Posterior pole view · CFP: 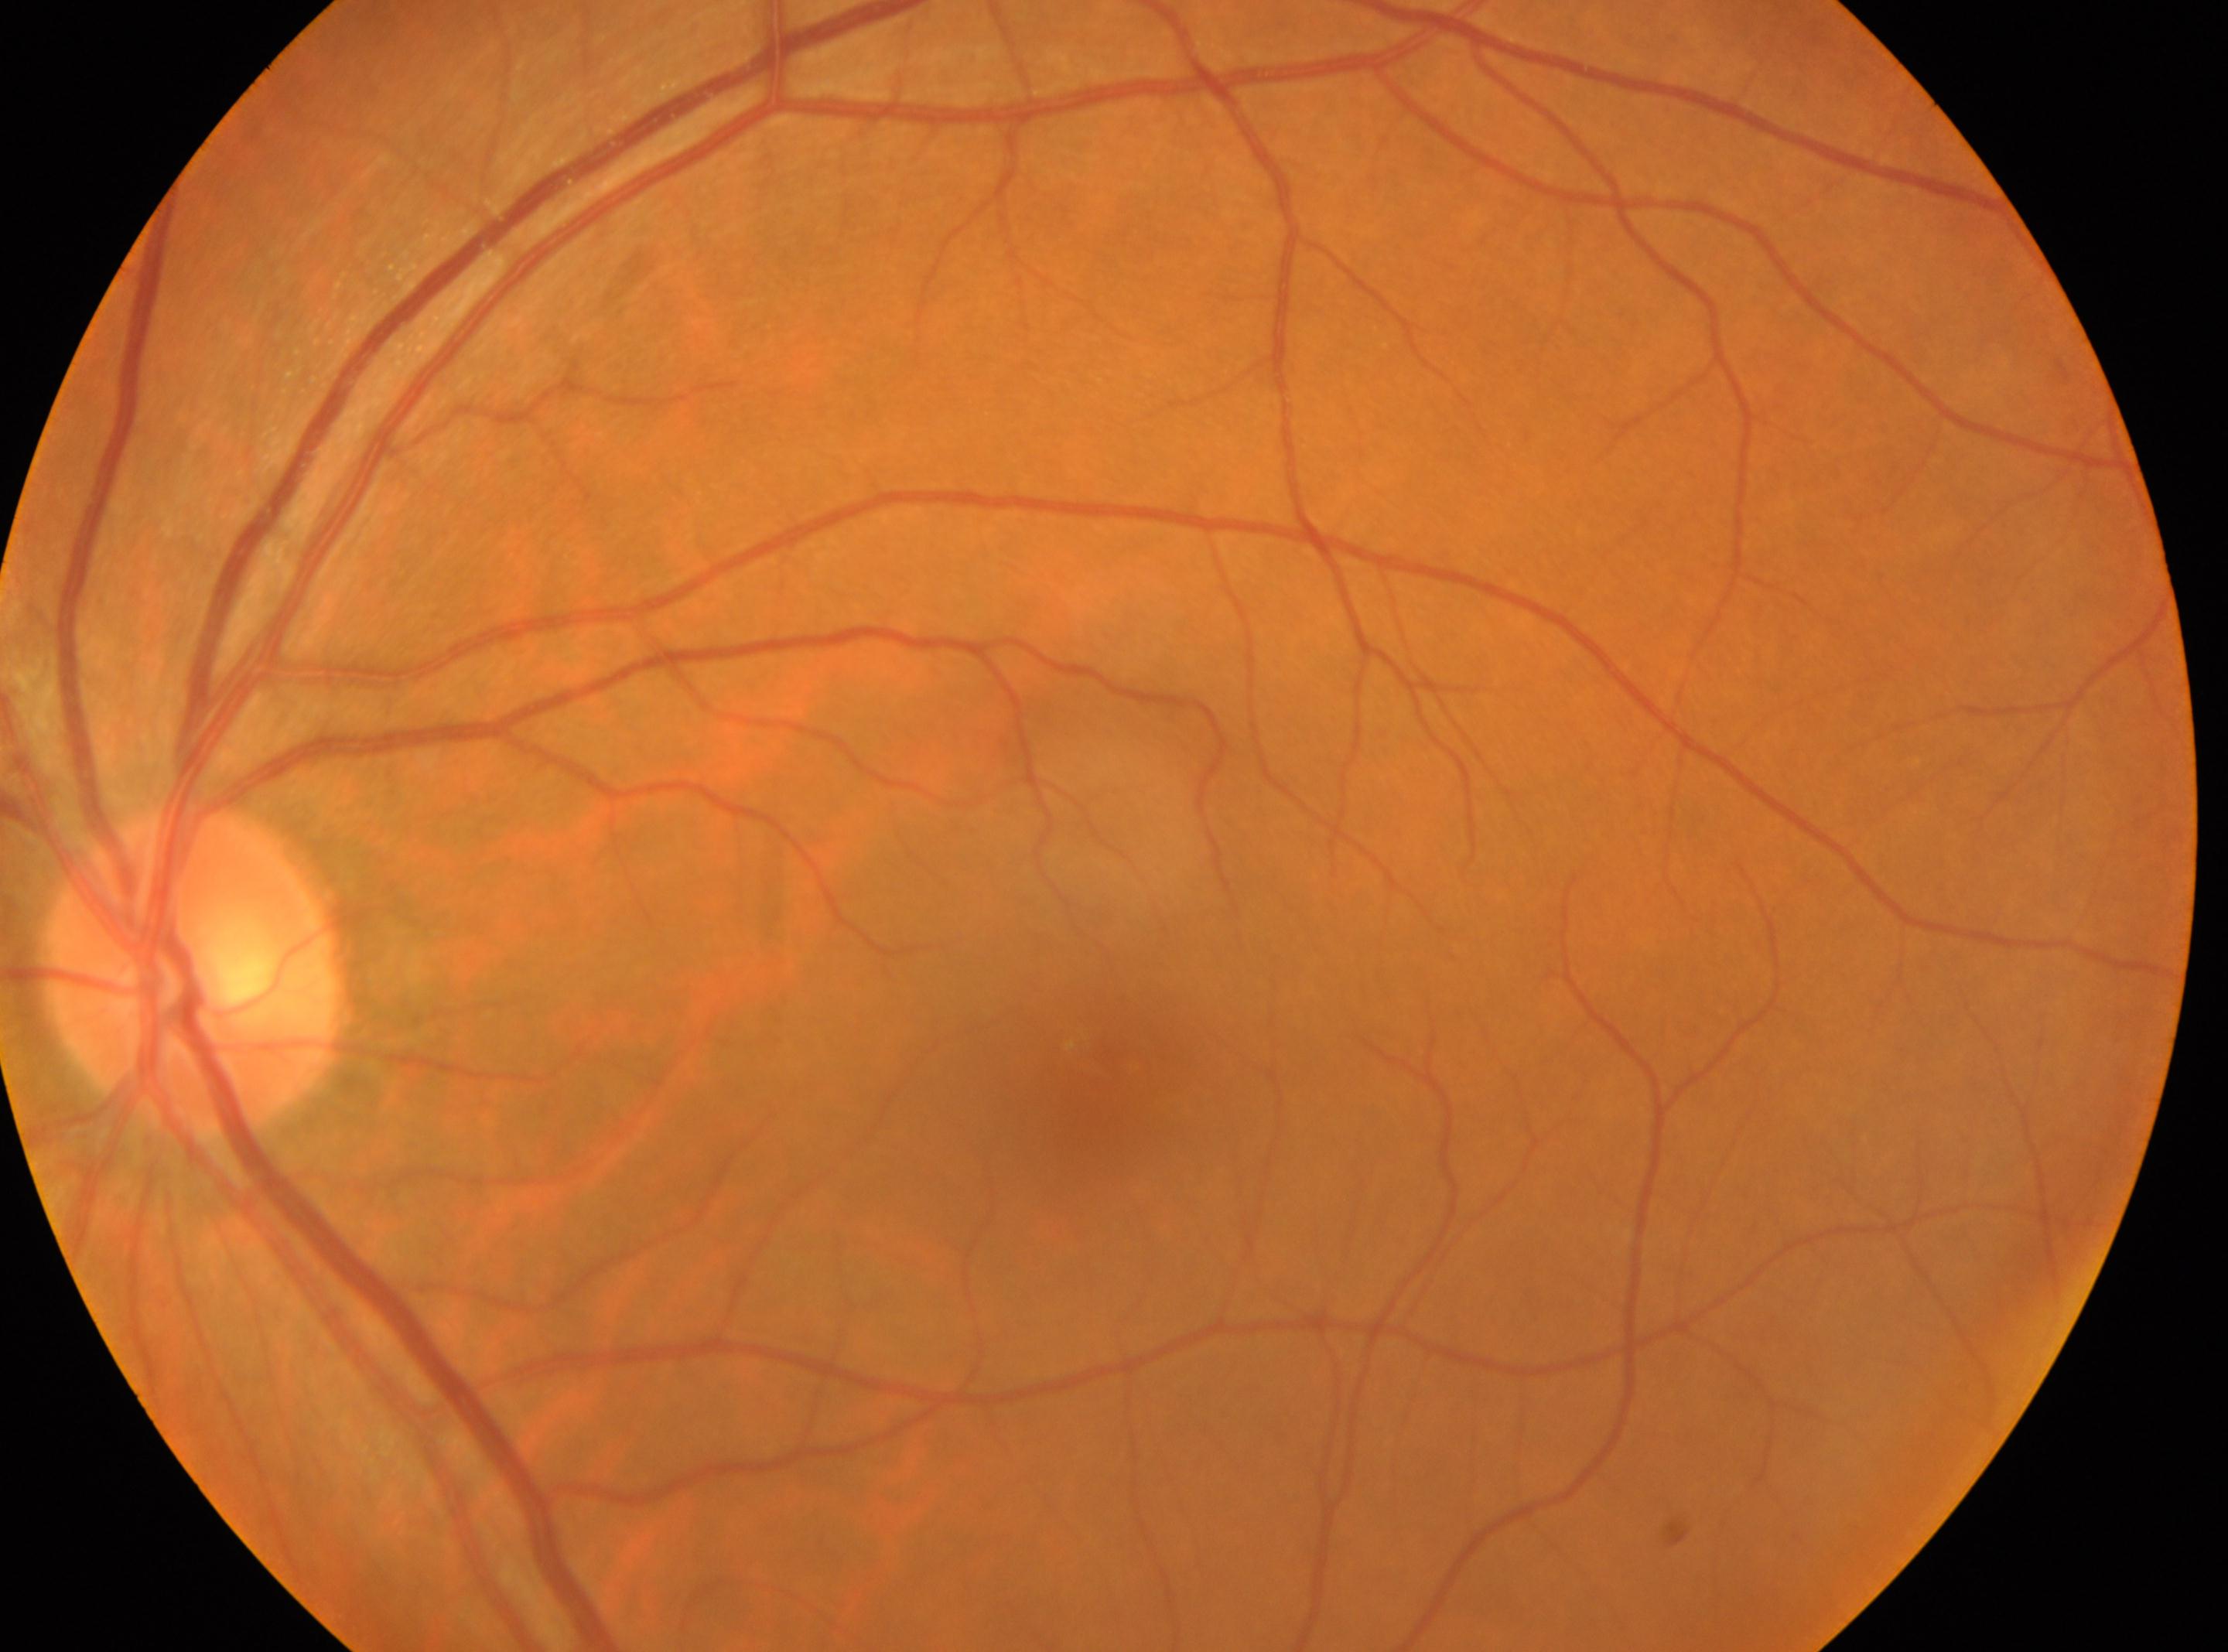 Foveal center located at [1105, 1072].
Retinopathy is no apparent diabetic retinopathy (grade 0).
Optic disc located at [192, 969].
The image shows the oculus sinister.